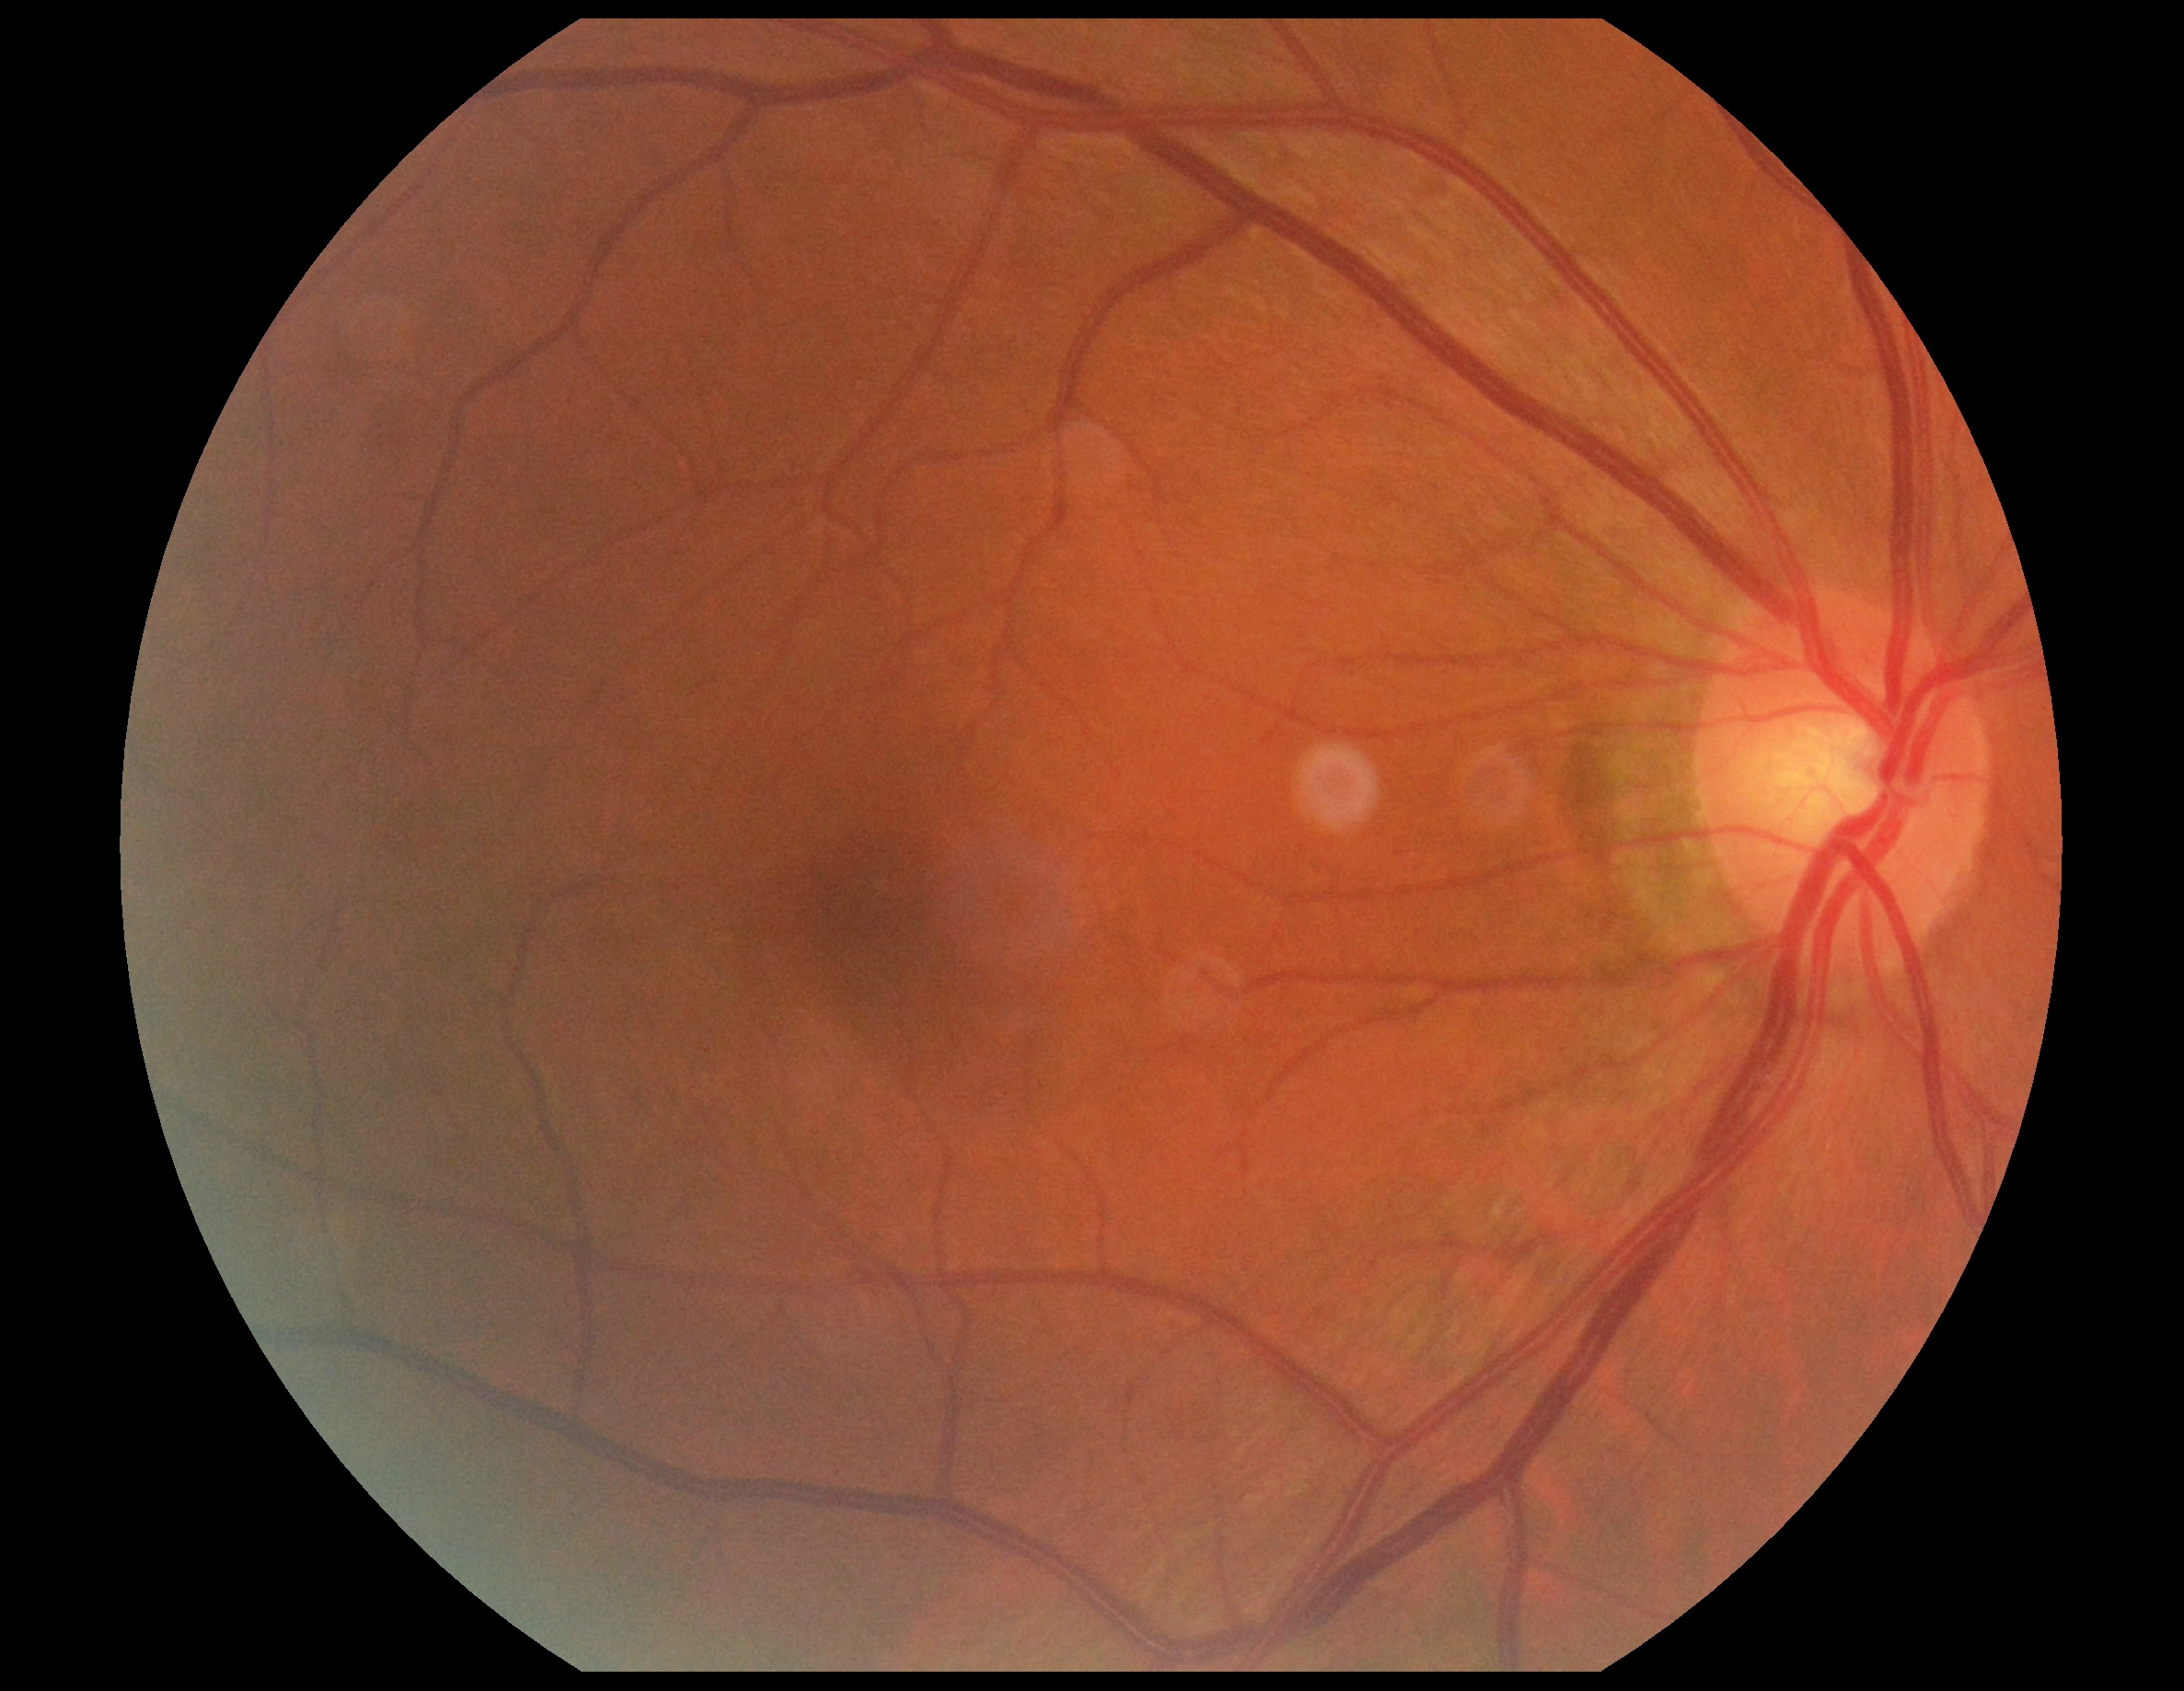
Diabetic retinopathy (DR) is no apparent diabetic retinopathy (grade 0).